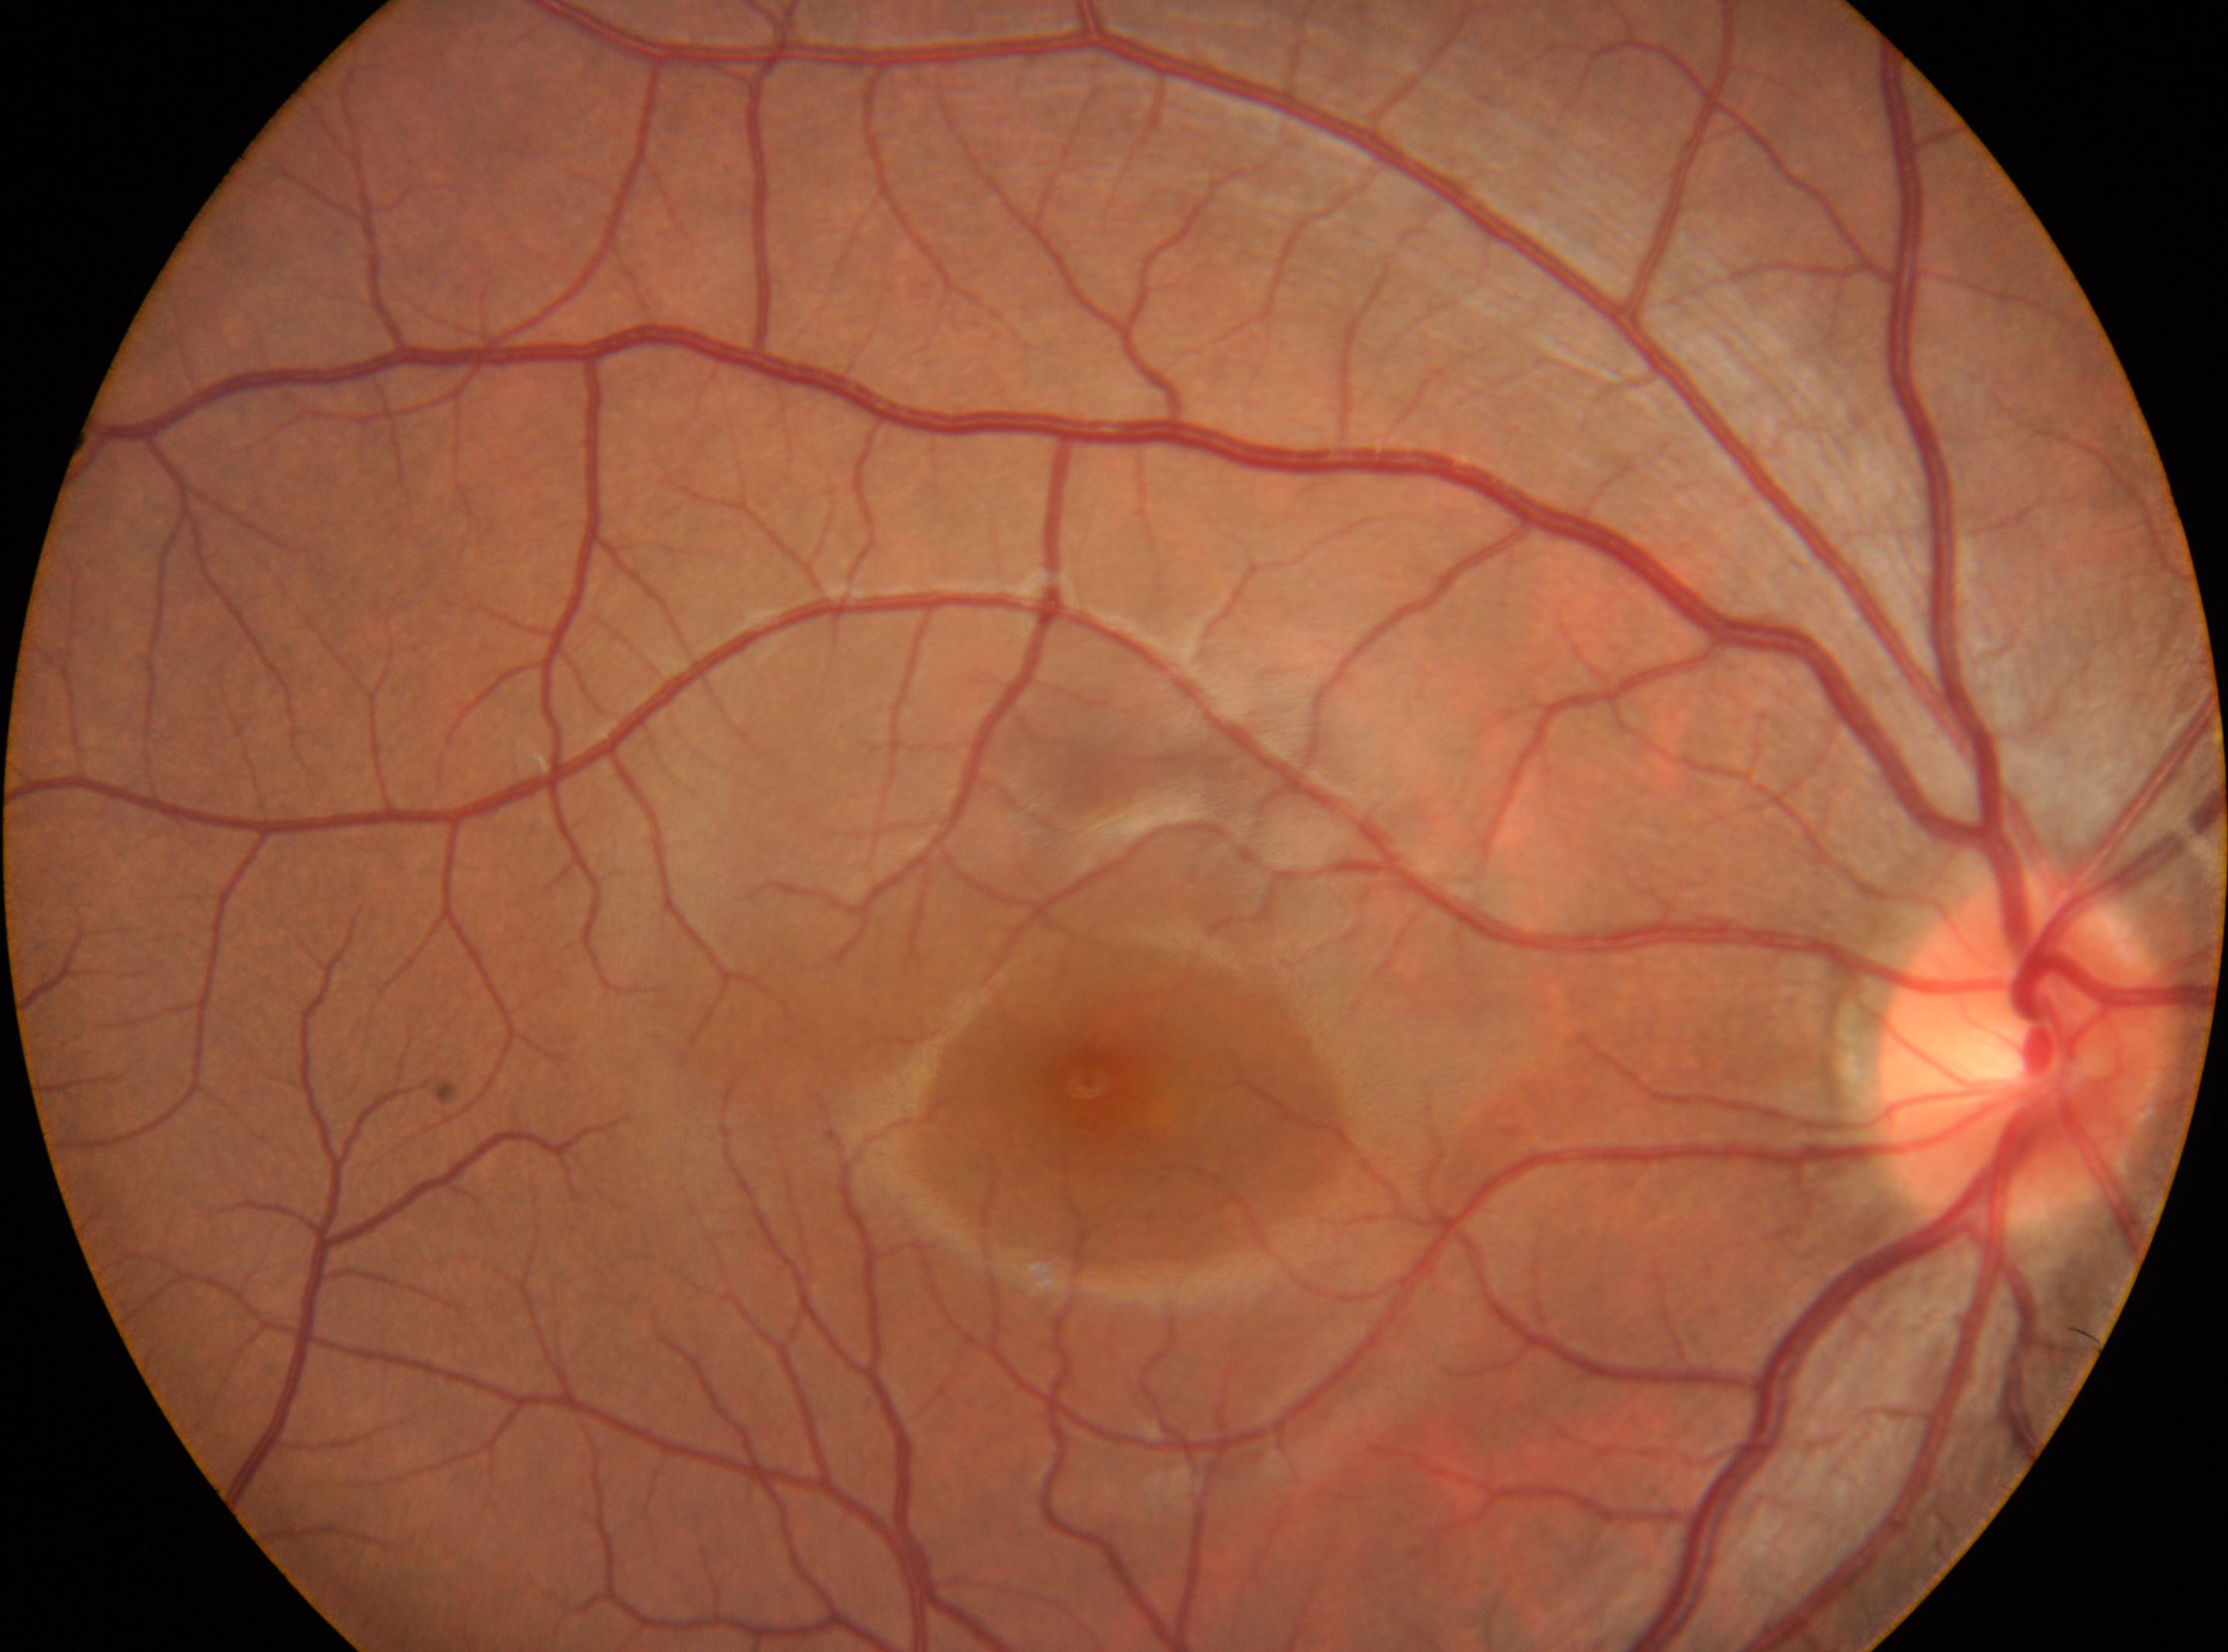 {
  "dr_grade": "0",
  "optic_disc": "2021px, 1047px",
  "eye": "OD",
  "fovea": "1088px, 1080px"
}